Patient age: 59 years; gender: F; autorefraction: sphere -1.5 D, cylinder -1.5 D, axis 130° — 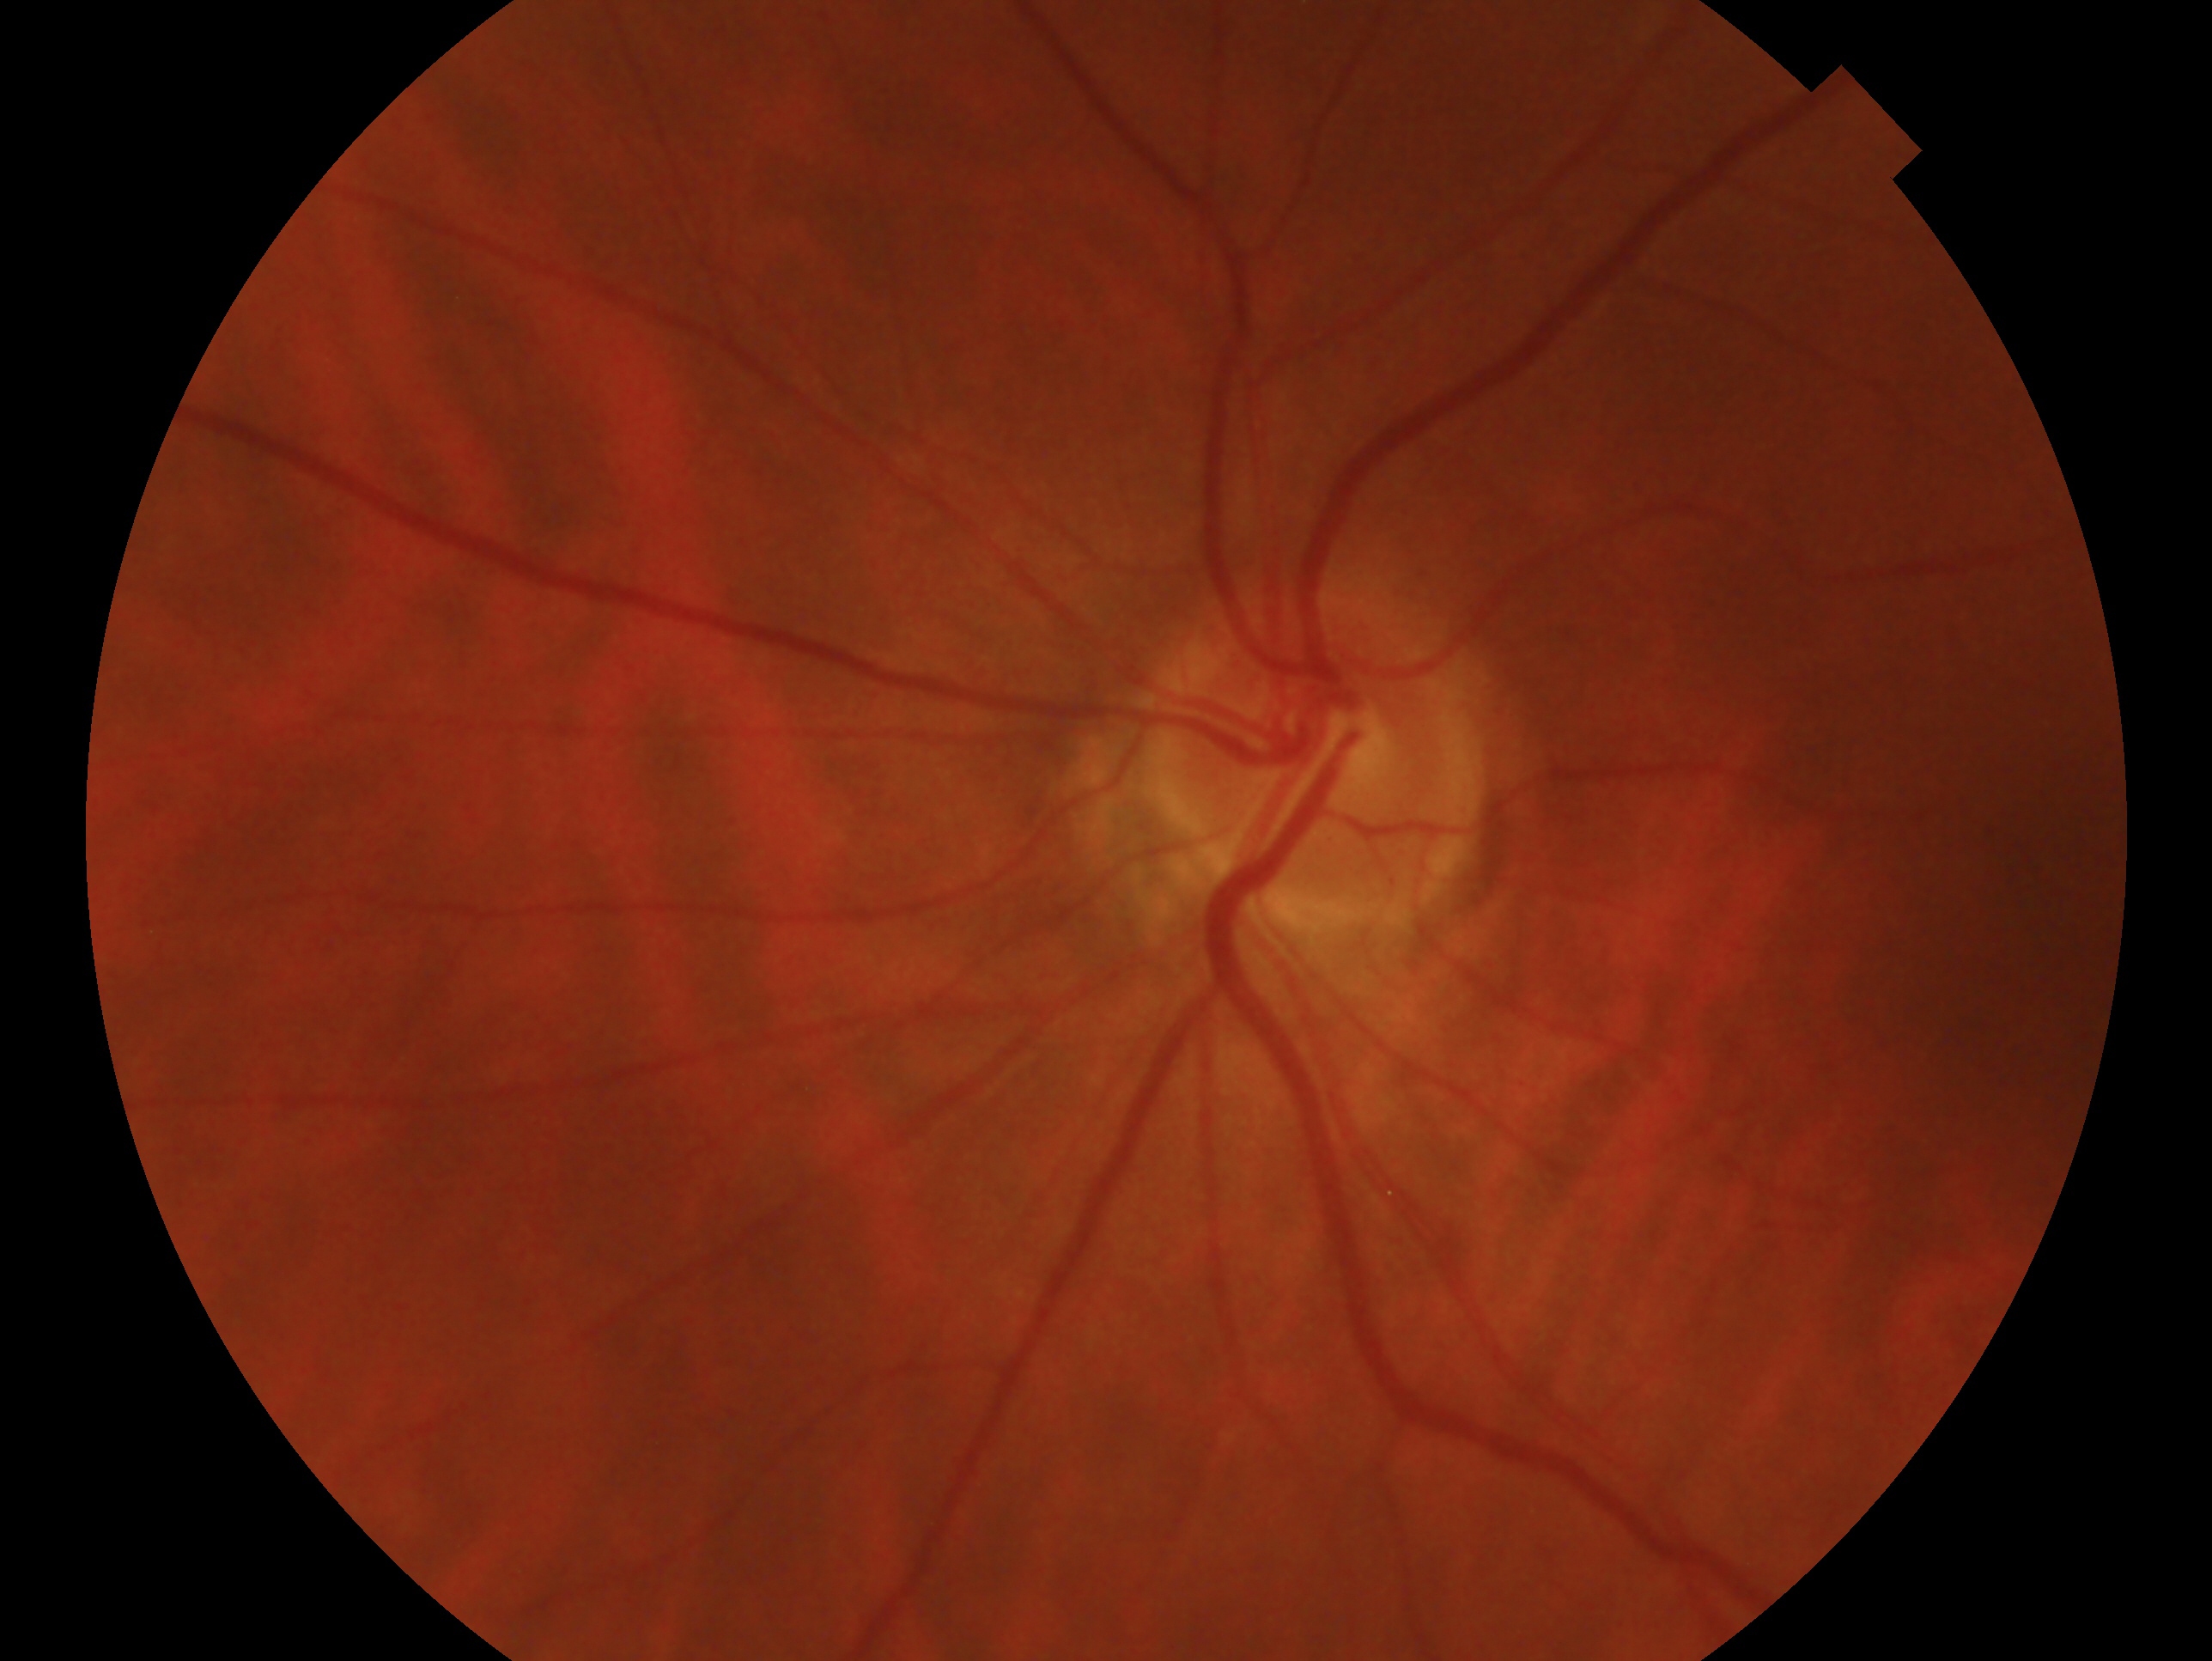

Q: Right or left eye?
A: left eye
Q: Glaucoma classification?
A: no glaucomatous findings